2352x1568px — 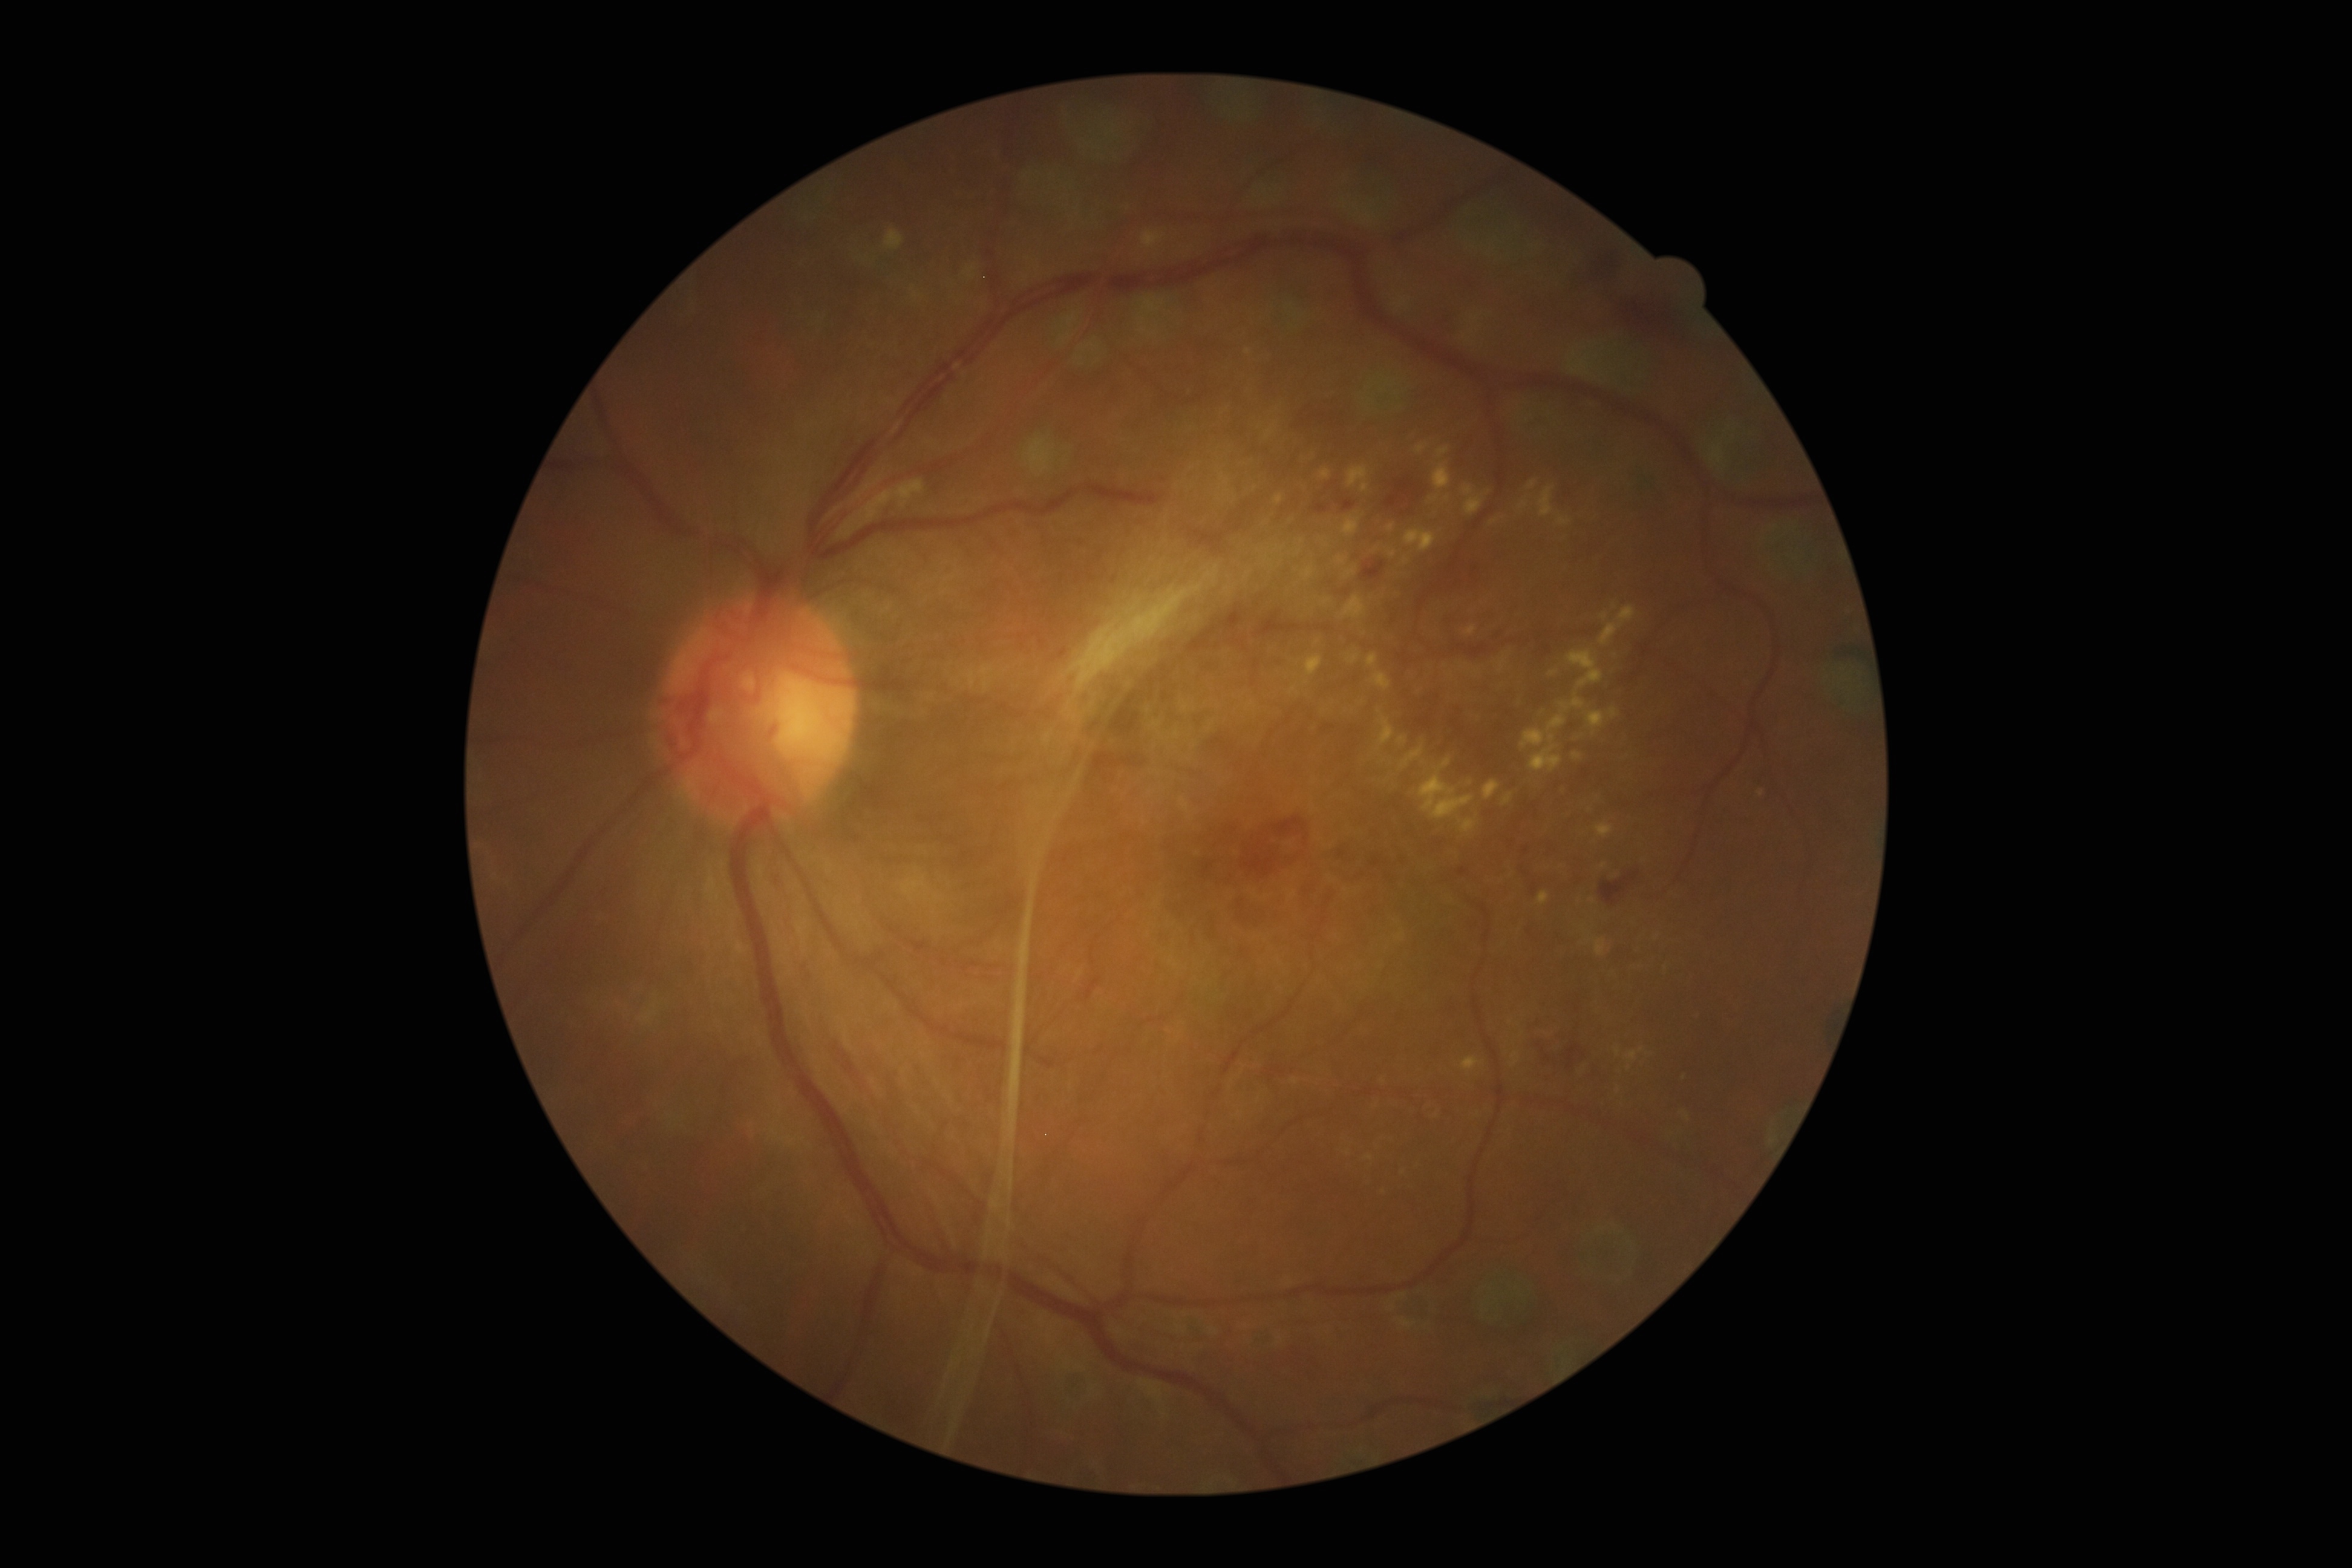 Diabetic retinopathy severity: 4.